Color fundus photograph · FOV: 45 degrees · 1380x1382px.
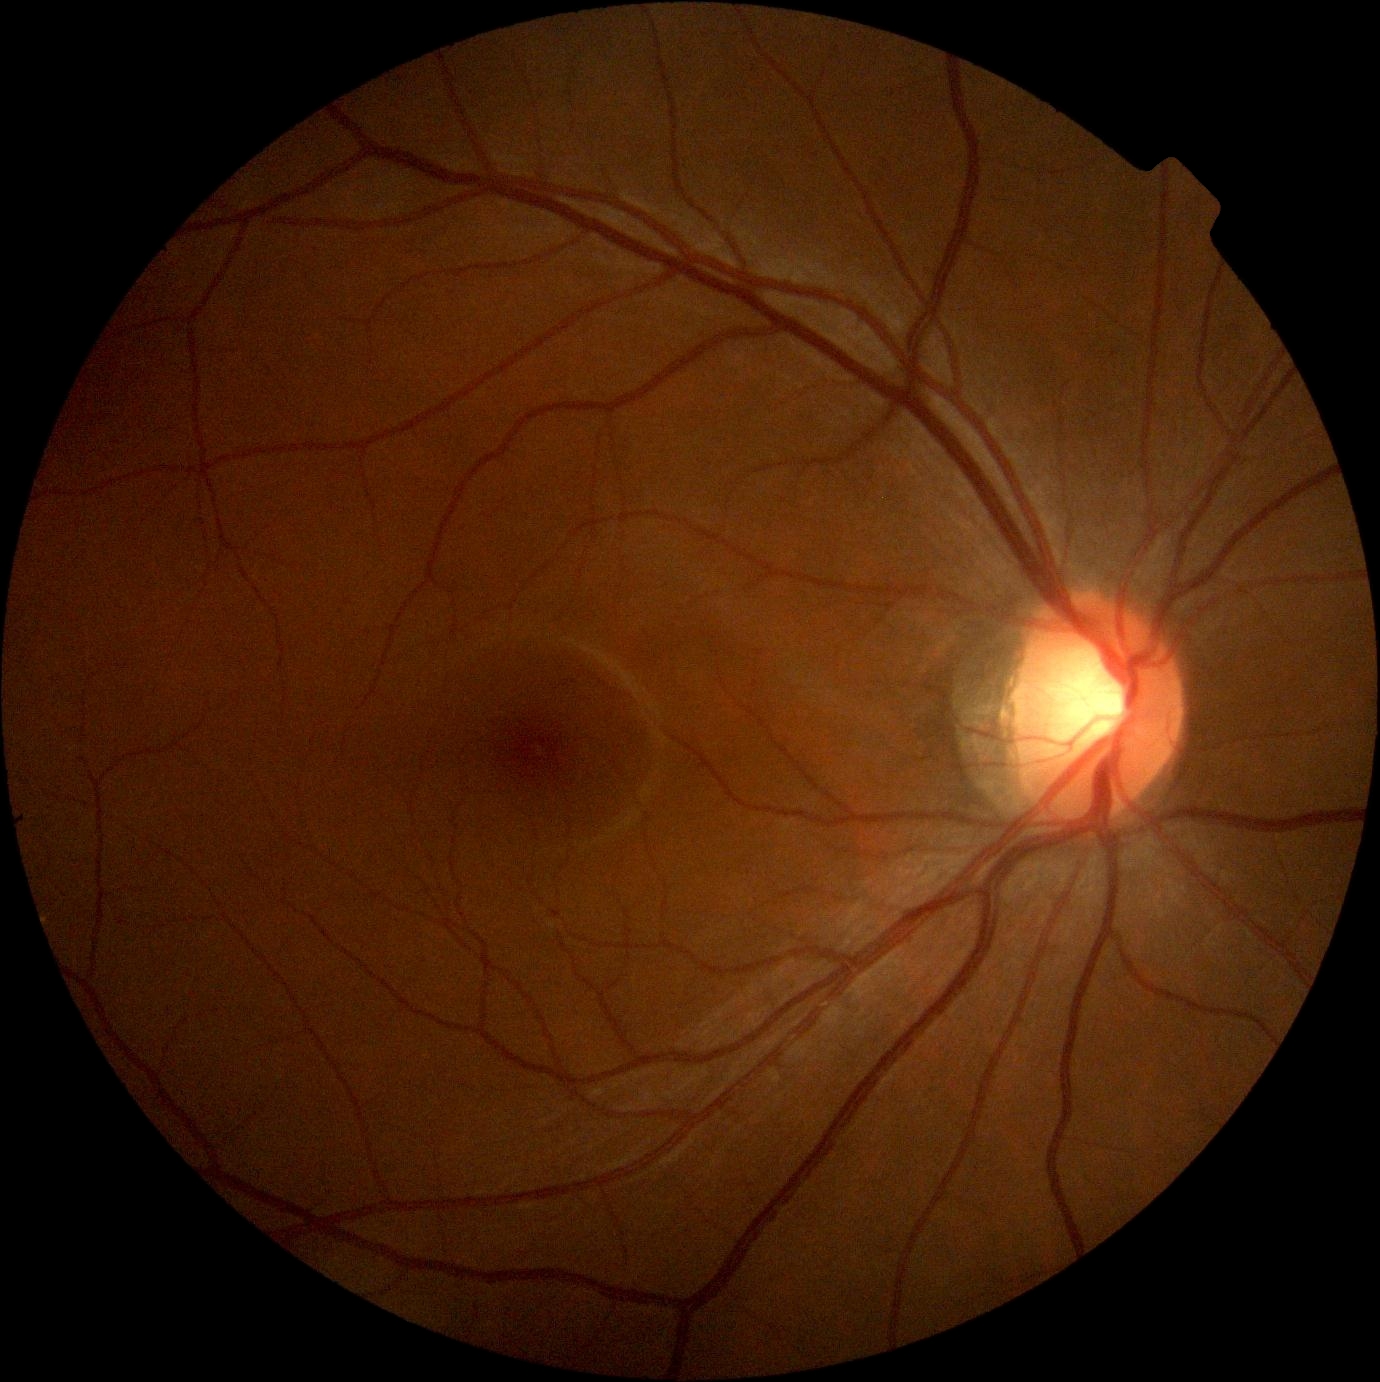
DR severity: grade 0.
No signs of diabetic retinopathy.